Diabetic retinopathy graded by the modified Davis classification:
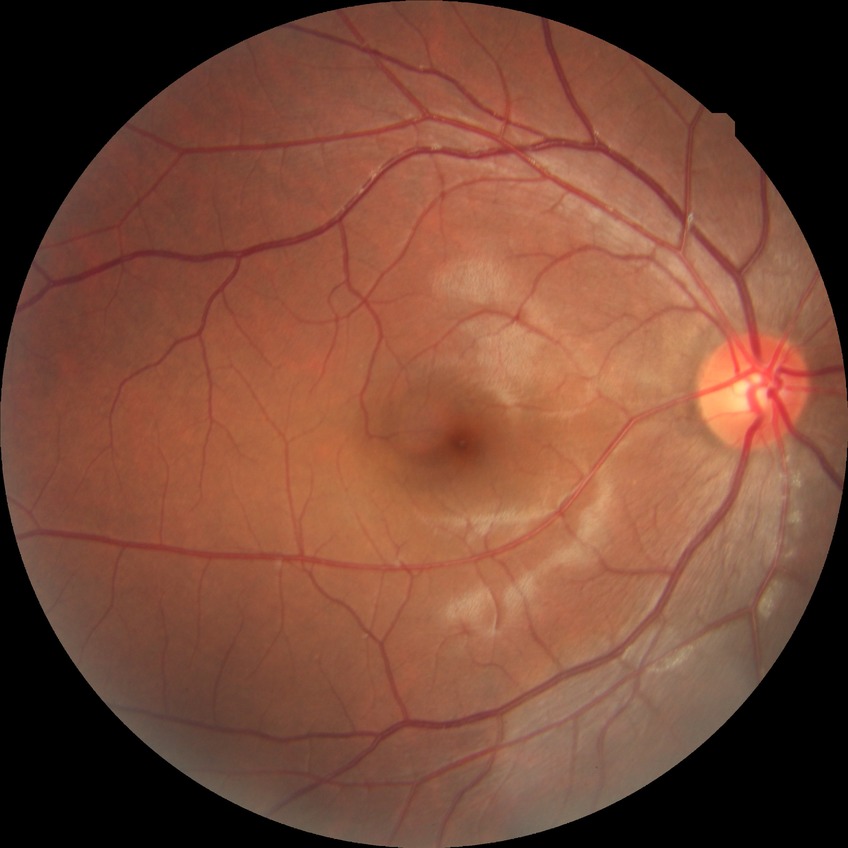
– diabetic retinopathy (DR): no diabetic retinopathy (NDR)